Color fundus photograph.
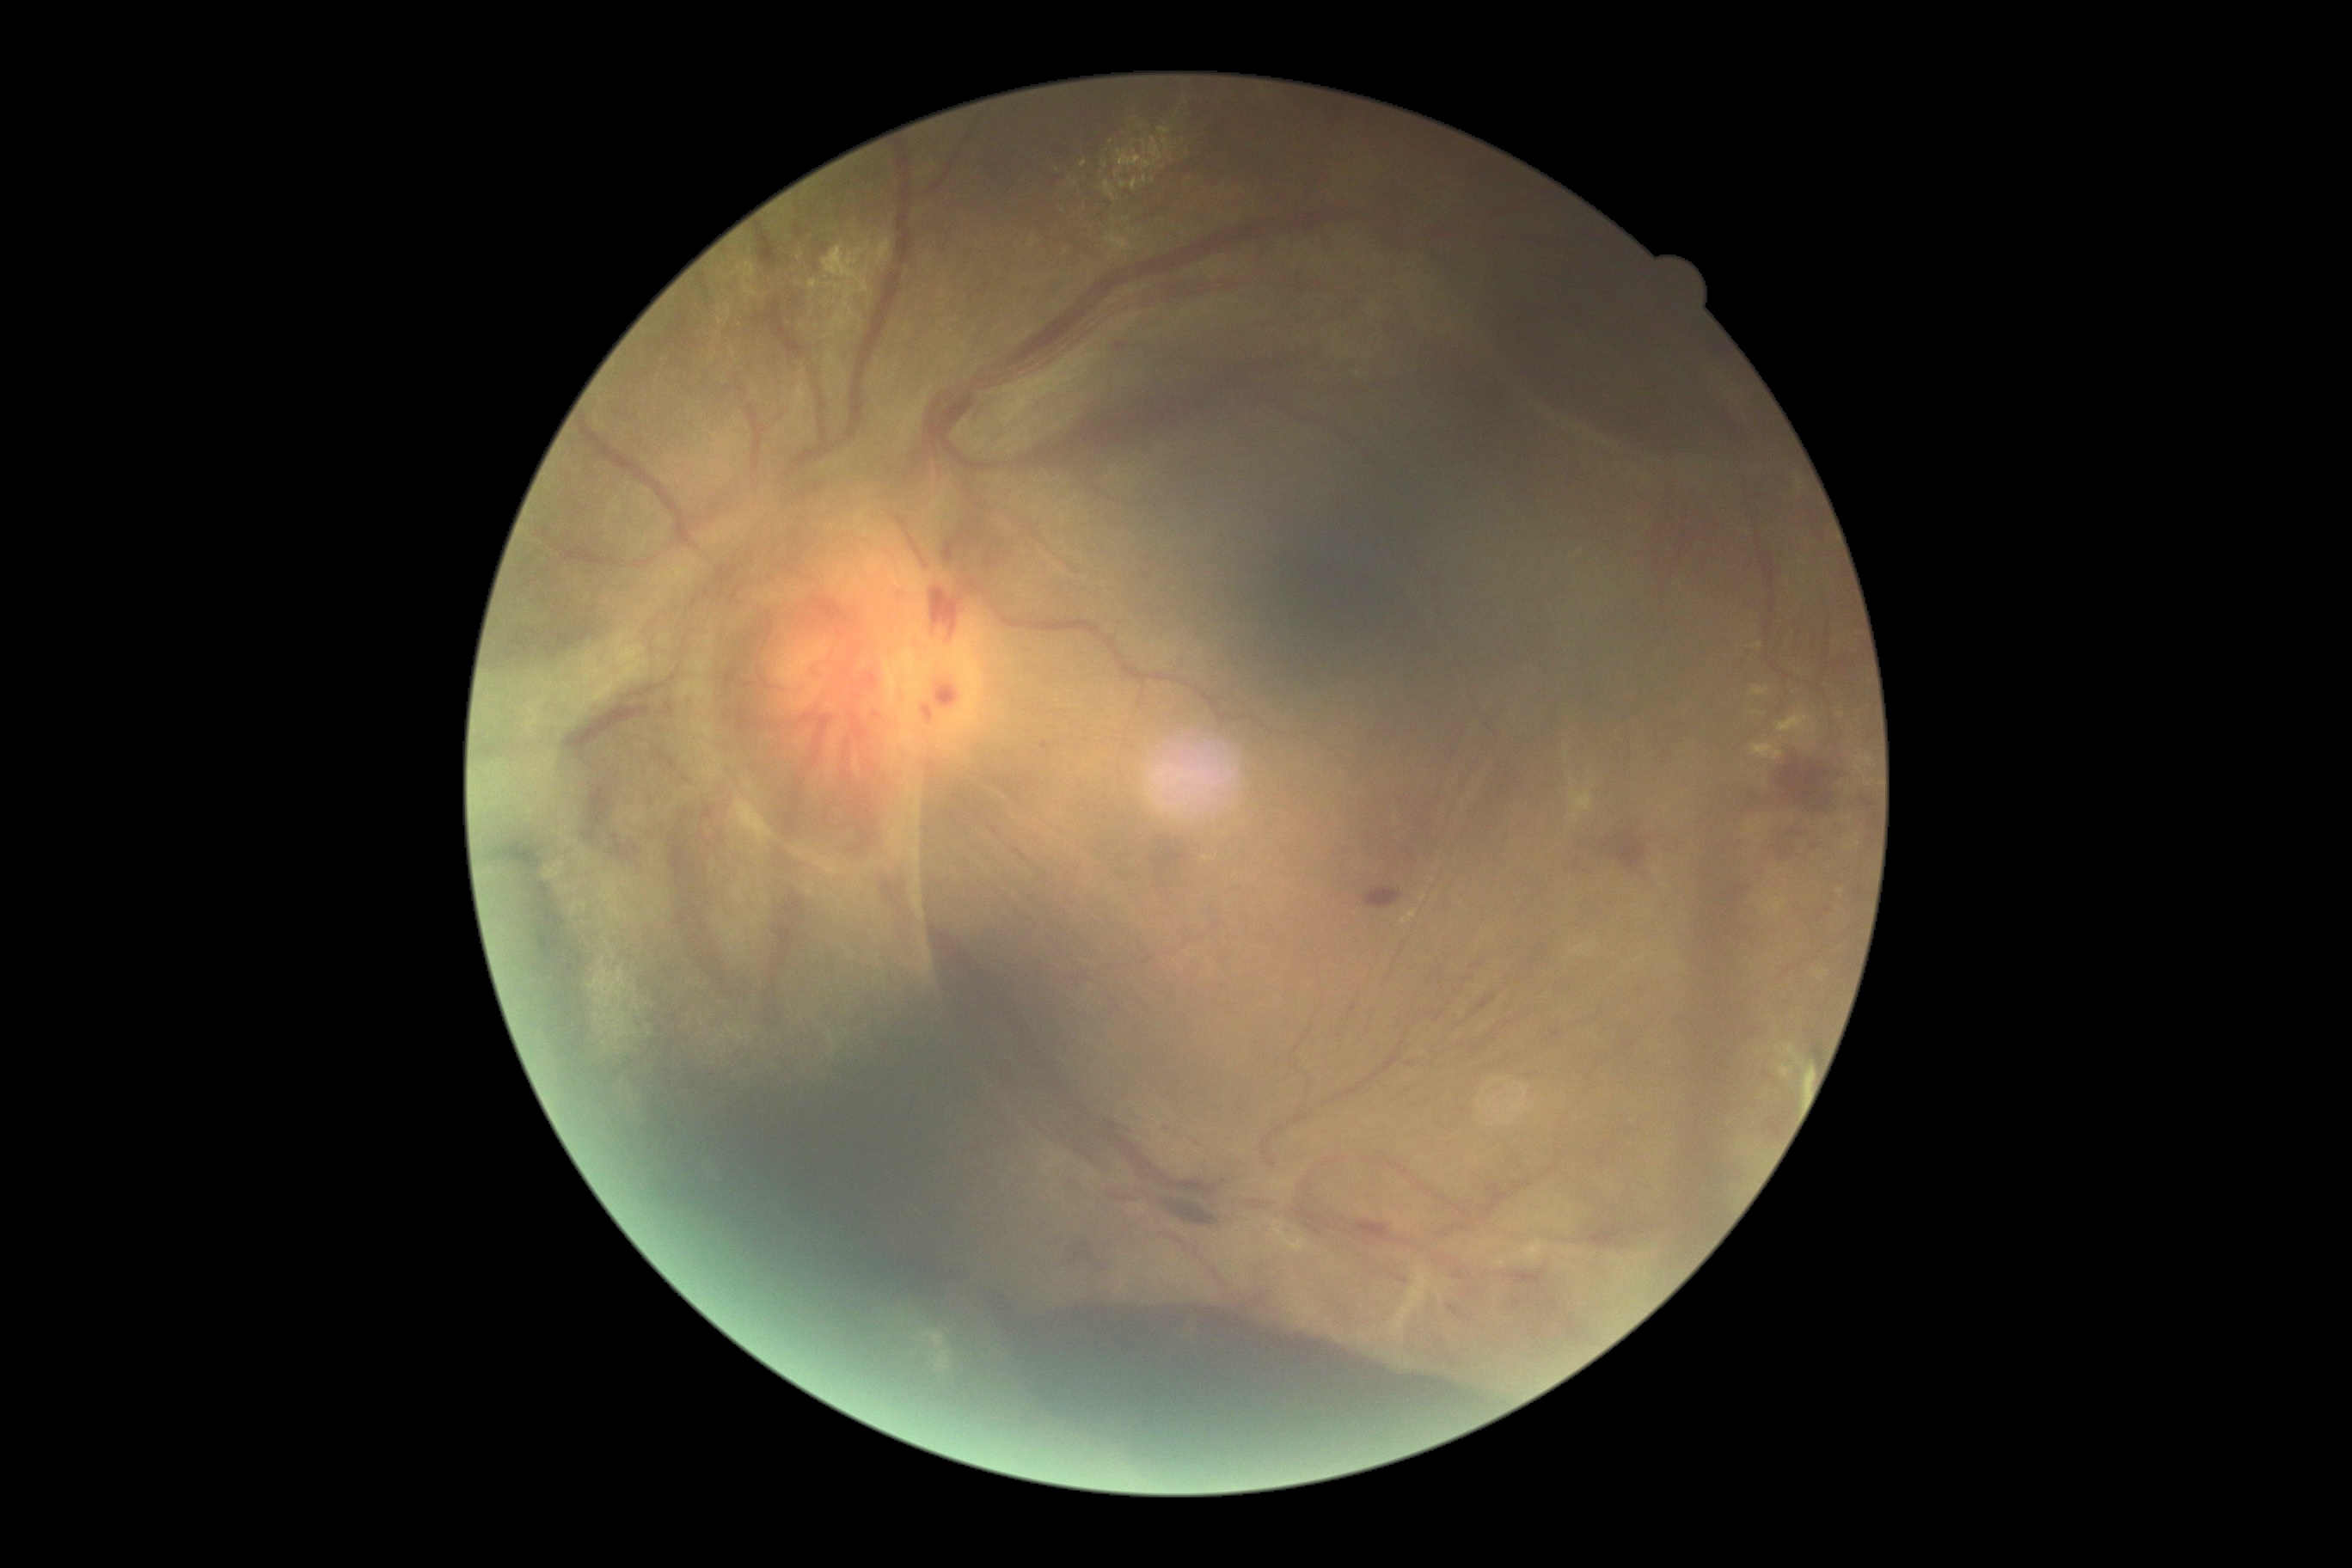

Findings:
• diabetic retinopathy: 4/4 — neovascularization and/or vitreous/pre-retinal hemorrhage
• DR class: proliferative diabetic retinopathy